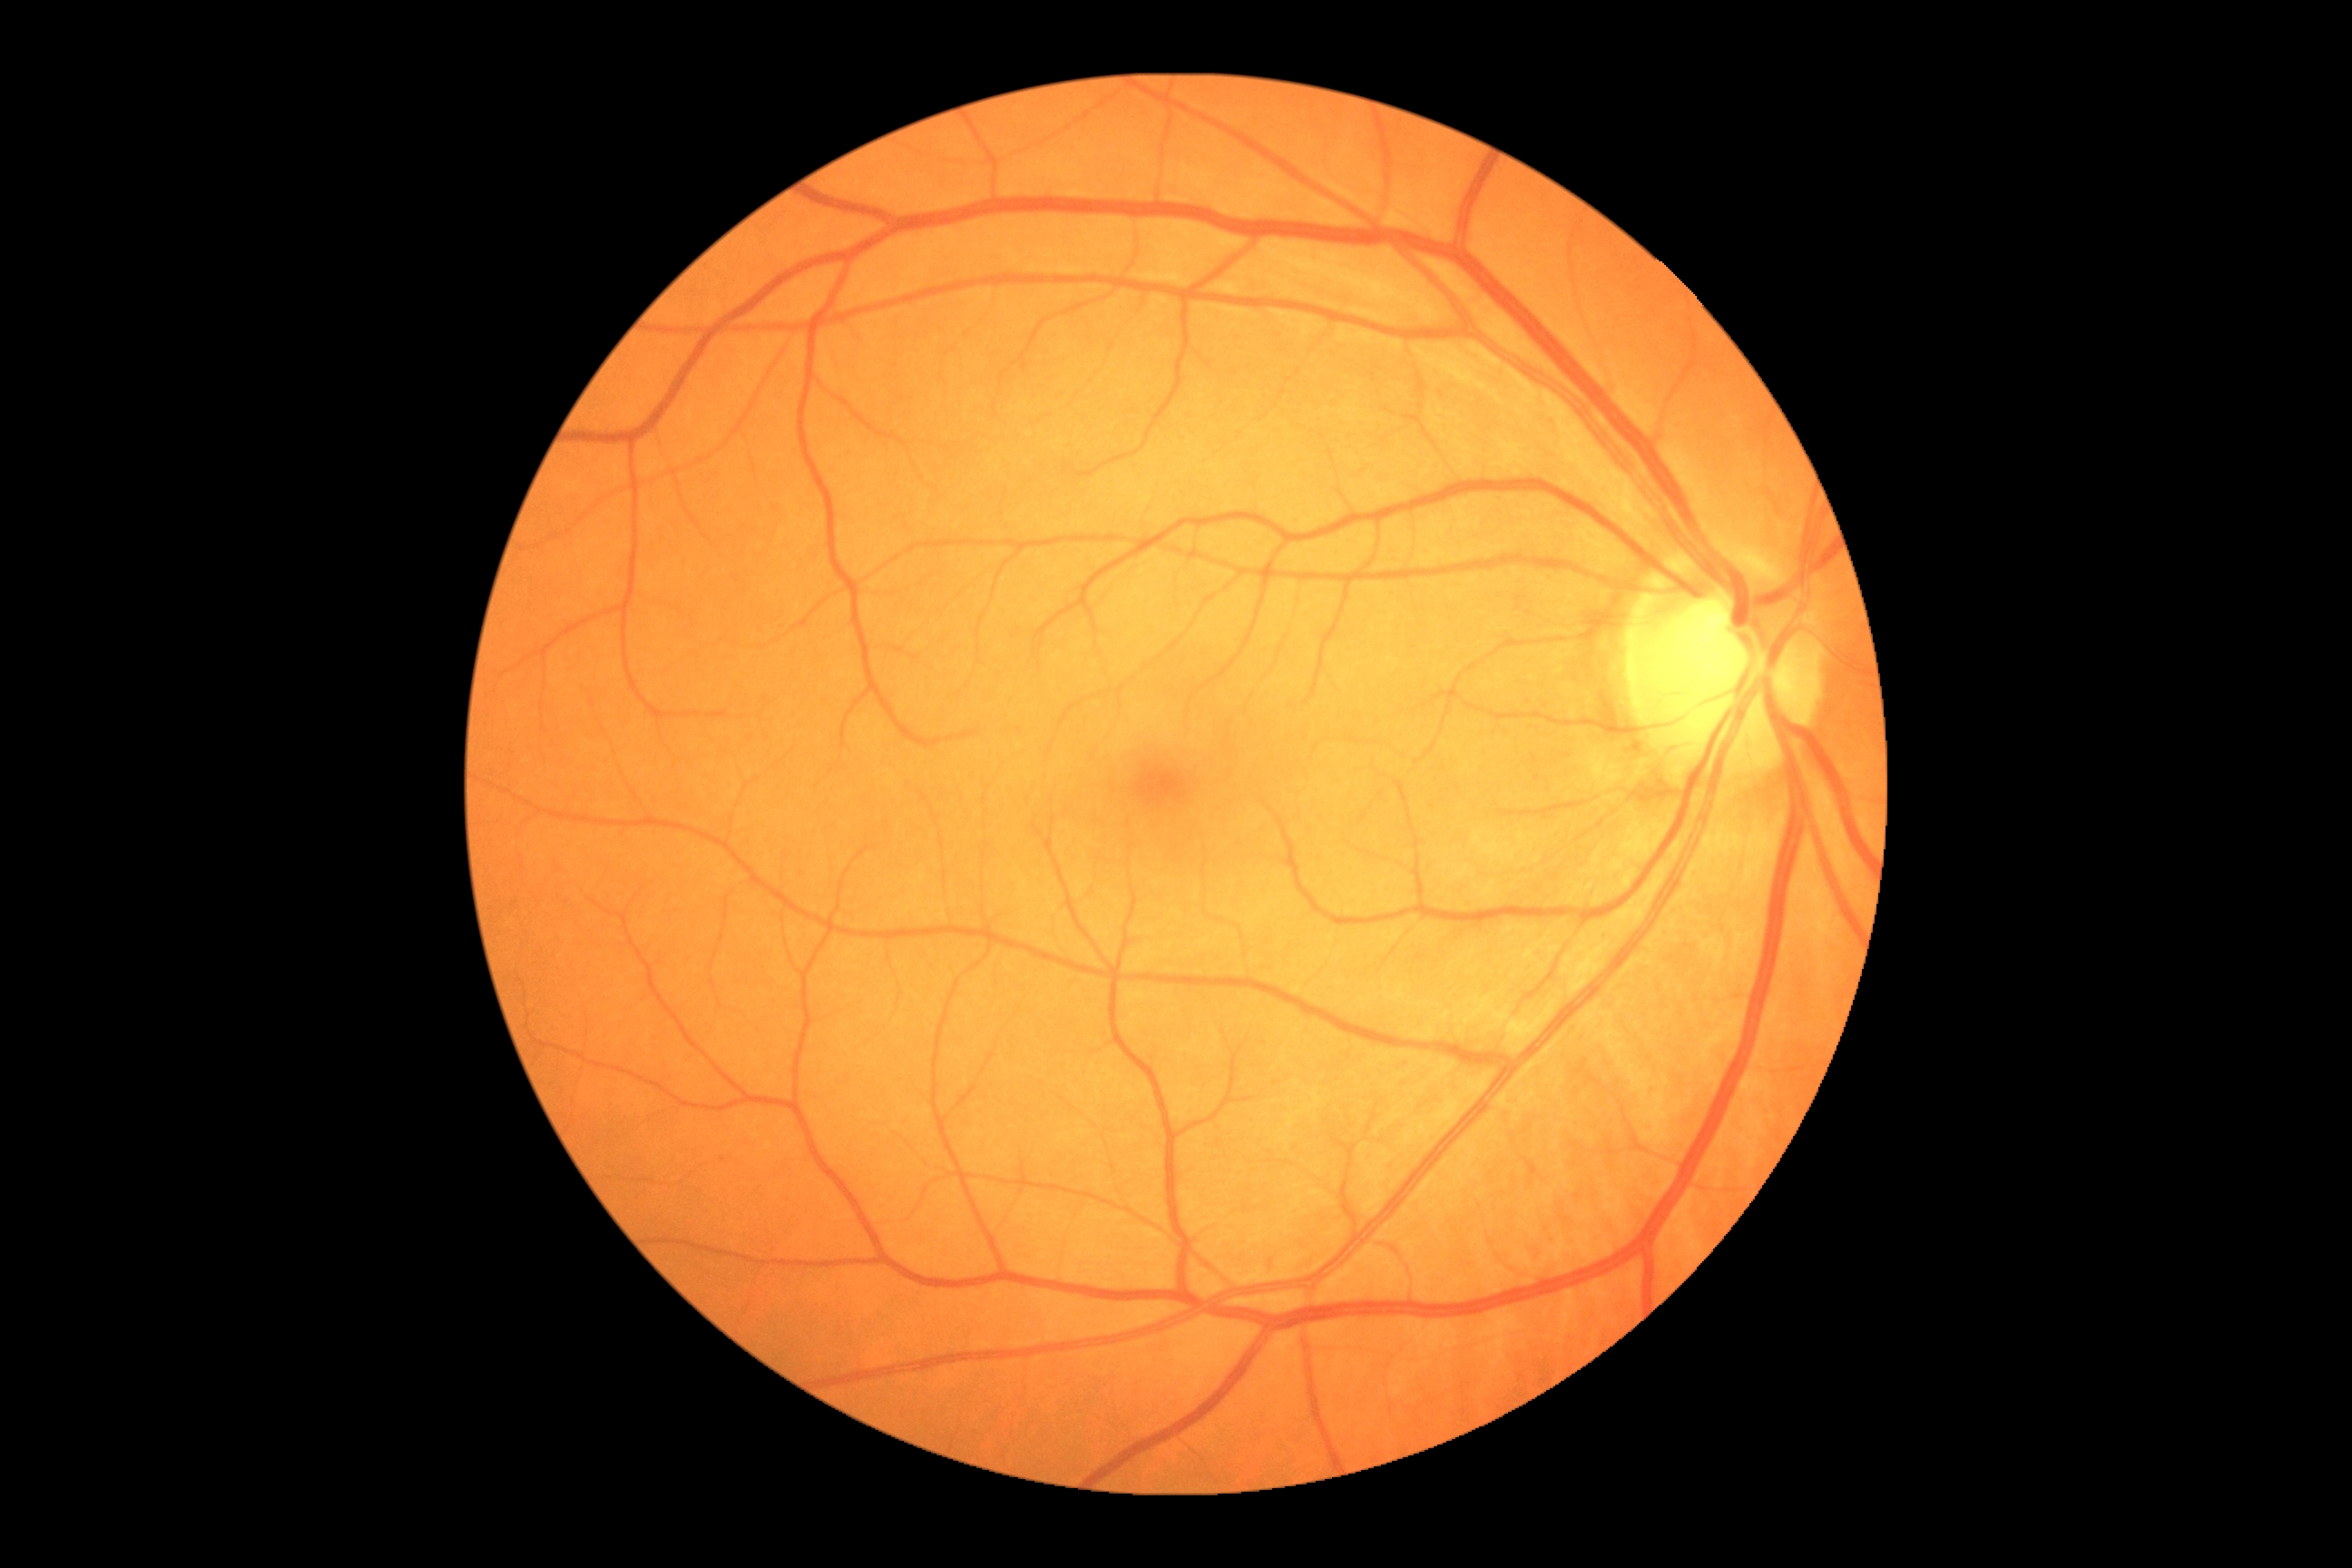 Findings:
• DR: grade 0 (no apparent retinopathy)
• DR impression: no apparent DR